45° FOV: 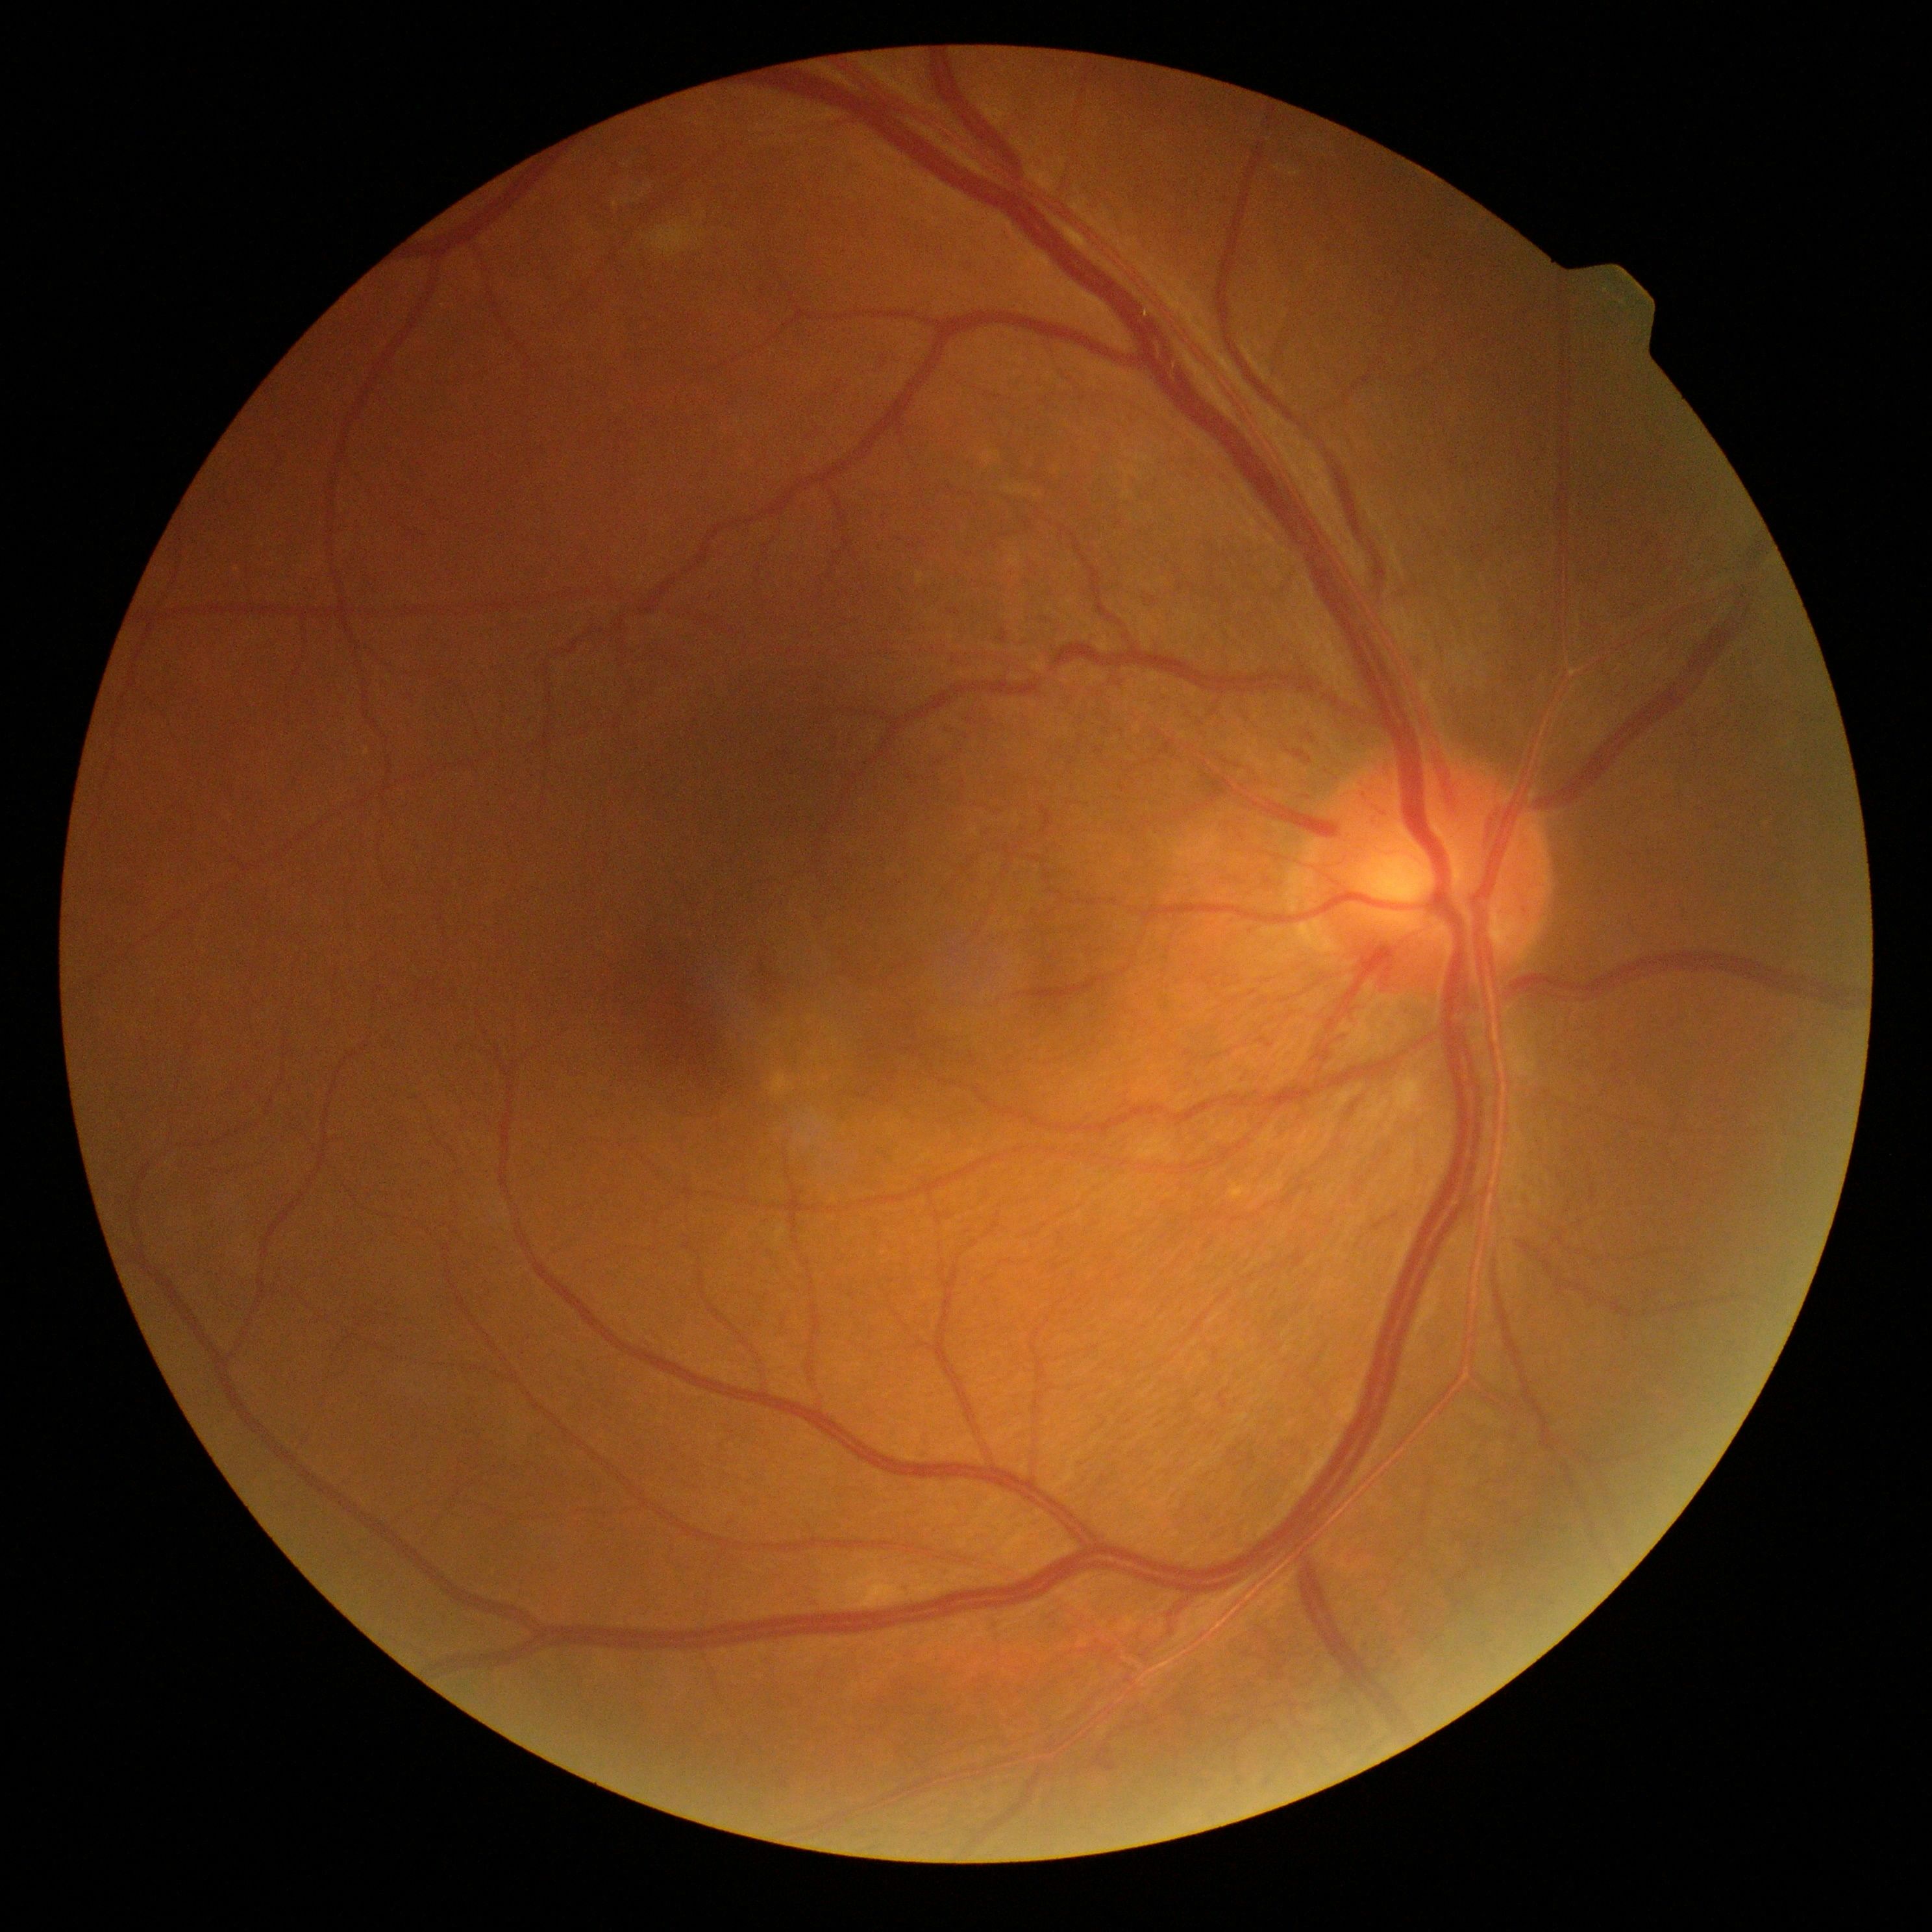
Diabetic retinopathy (DR) is 2.